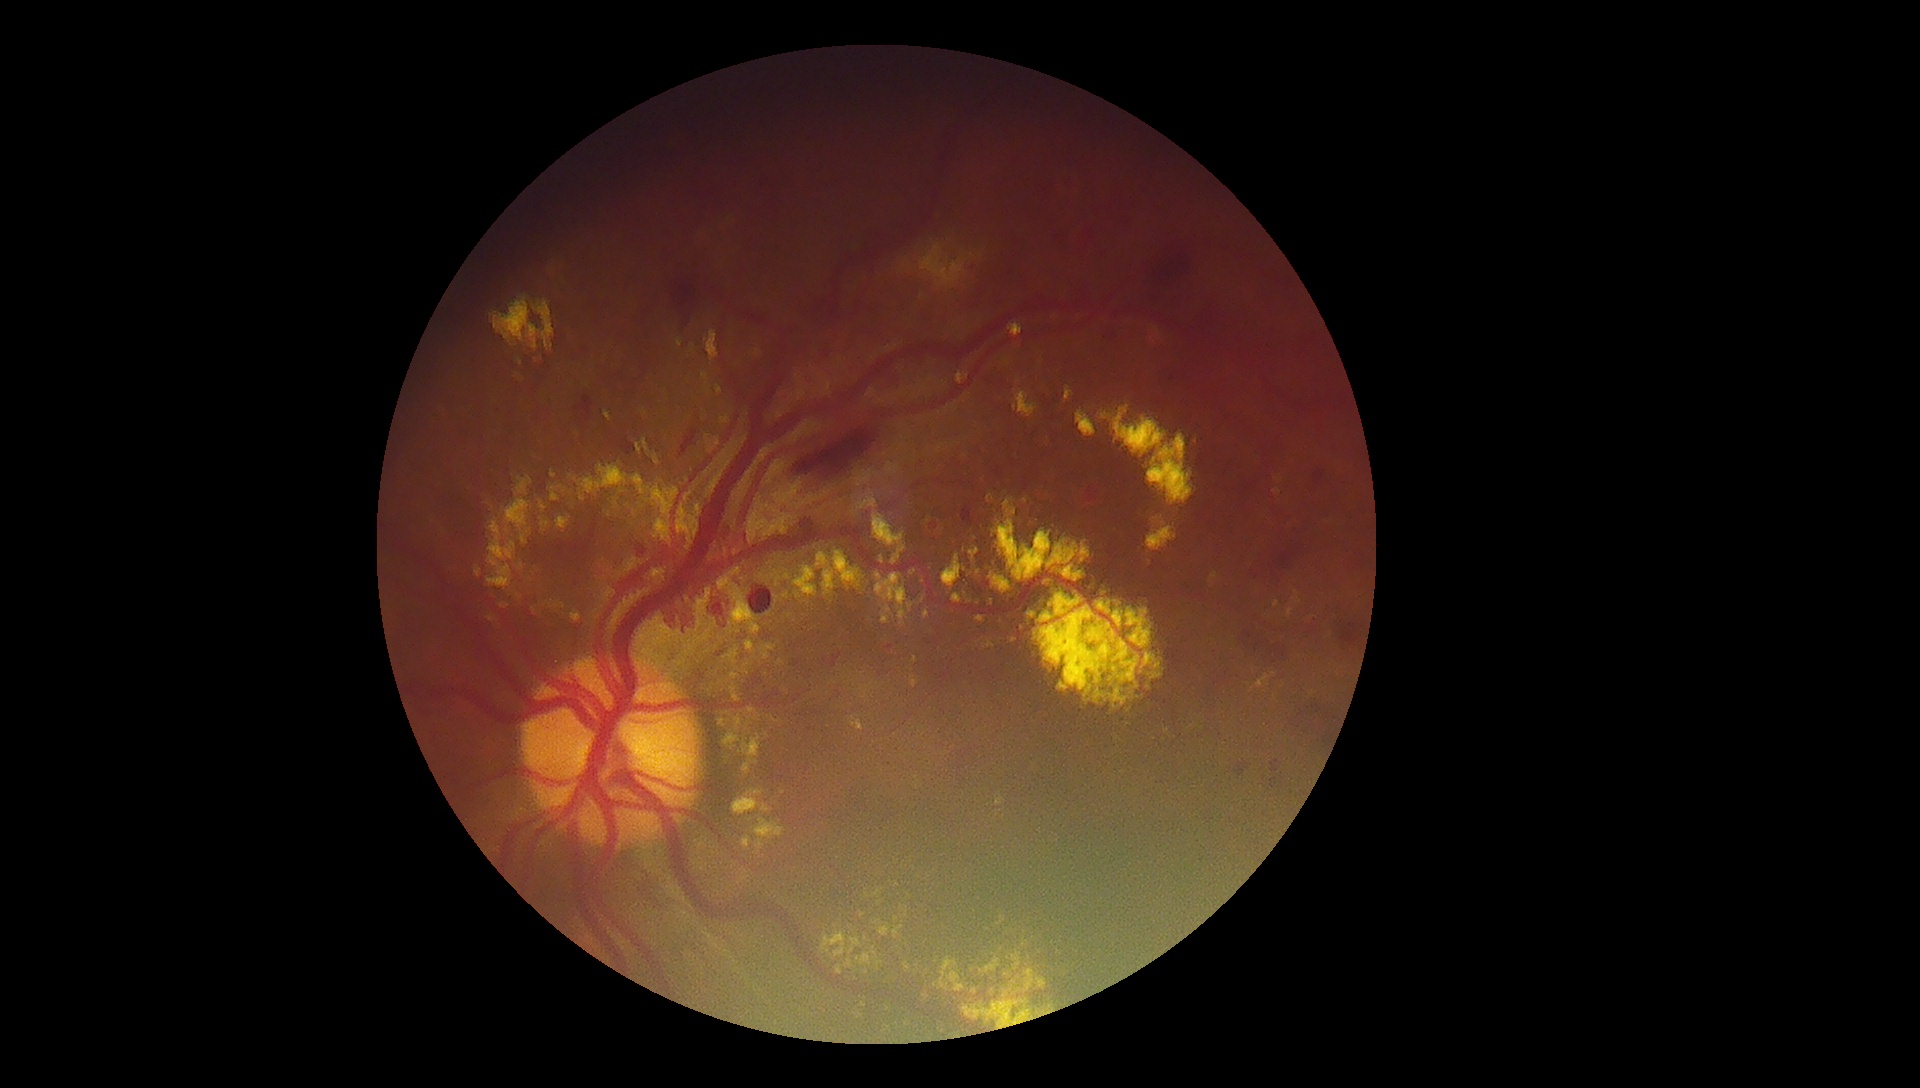 Retinopathy: 4
Representative lesions:
hard exudates (continued): box(677, 338, 684, 348); box(857, 490, 878, 511); box(490, 297, 541, 350); box(952, 594, 963, 604); box(723, 708, 762, 750); box(816, 553, 830, 568); box(723, 649, 739, 665); box(777, 659, 785, 666); box(987, 493, 995, 504); box(893, 926, 904, 940); box(934, 957, 958, 992)
Hard exudates (small, approximate centers) near Point(790, 616); Point(723, 691); Point(867, 973); Point(688, 600); Point(644, 411); Point(862, 915); Point(1277, 604)